Camera: Natus RetCam Envision (130° FOV); 1440x1080; RetCam wide-field infant fundus image
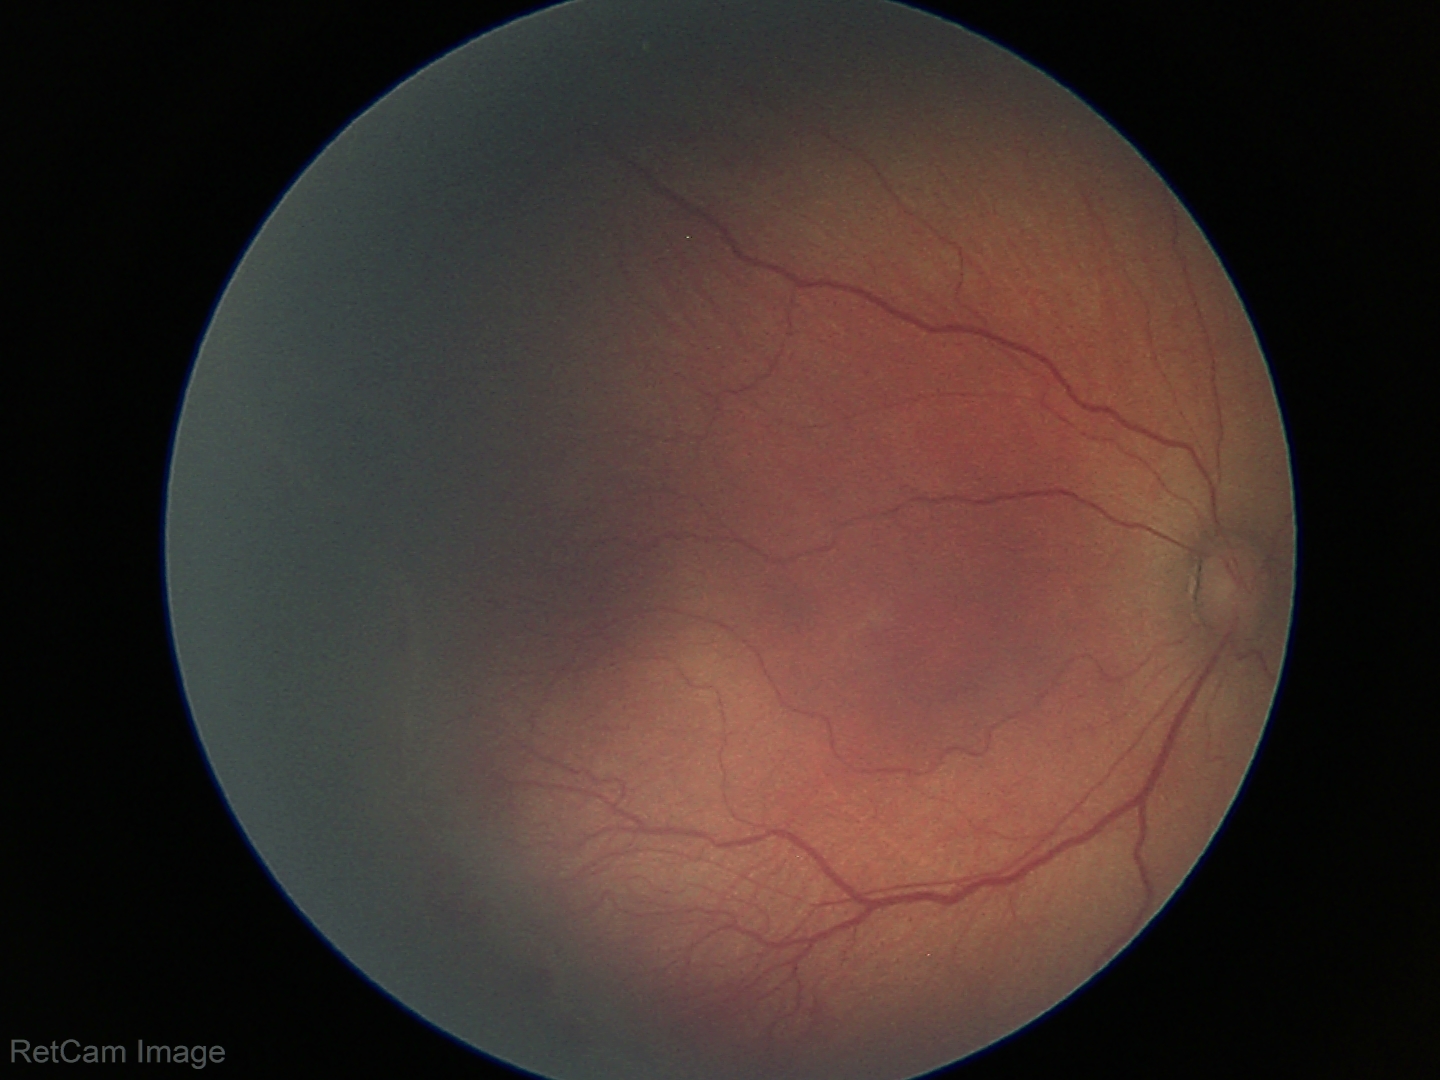

Examination diagnosed as ROP stage 2.